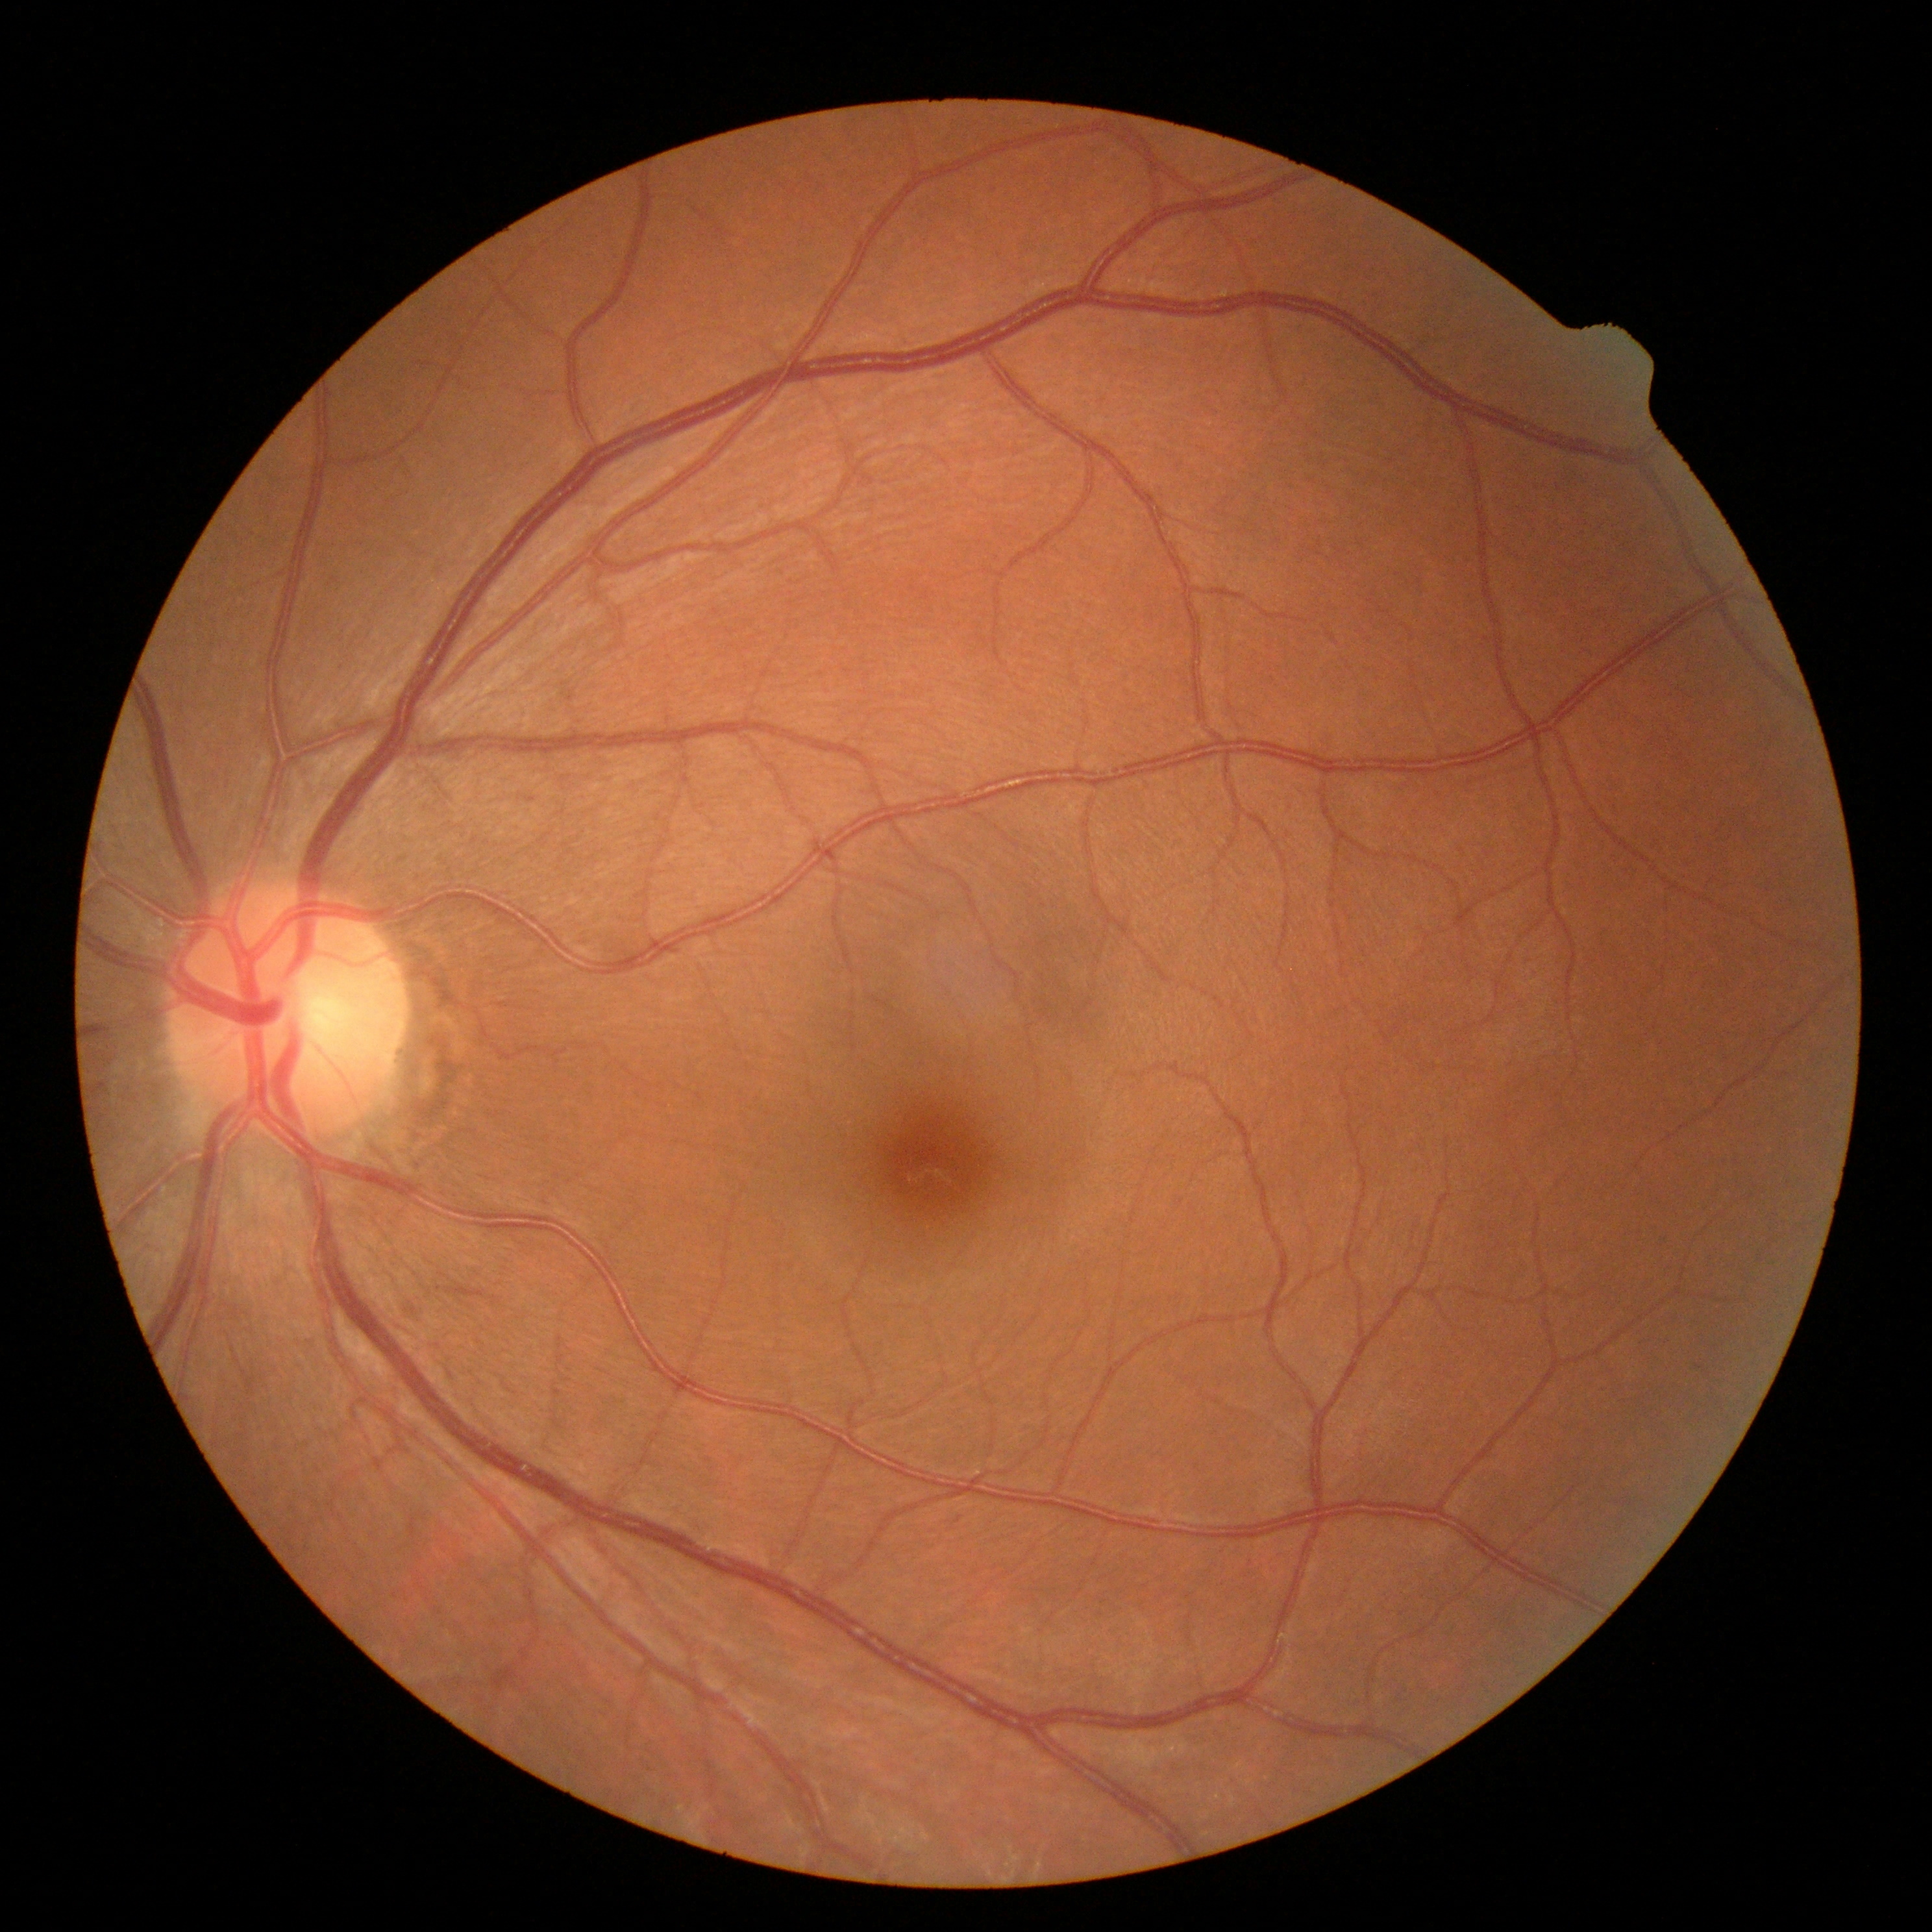
diabetic retinopathy = 0 — no visible signs of diabetic retinopathy